Fundus photo. 2352 x 1568 pixels — 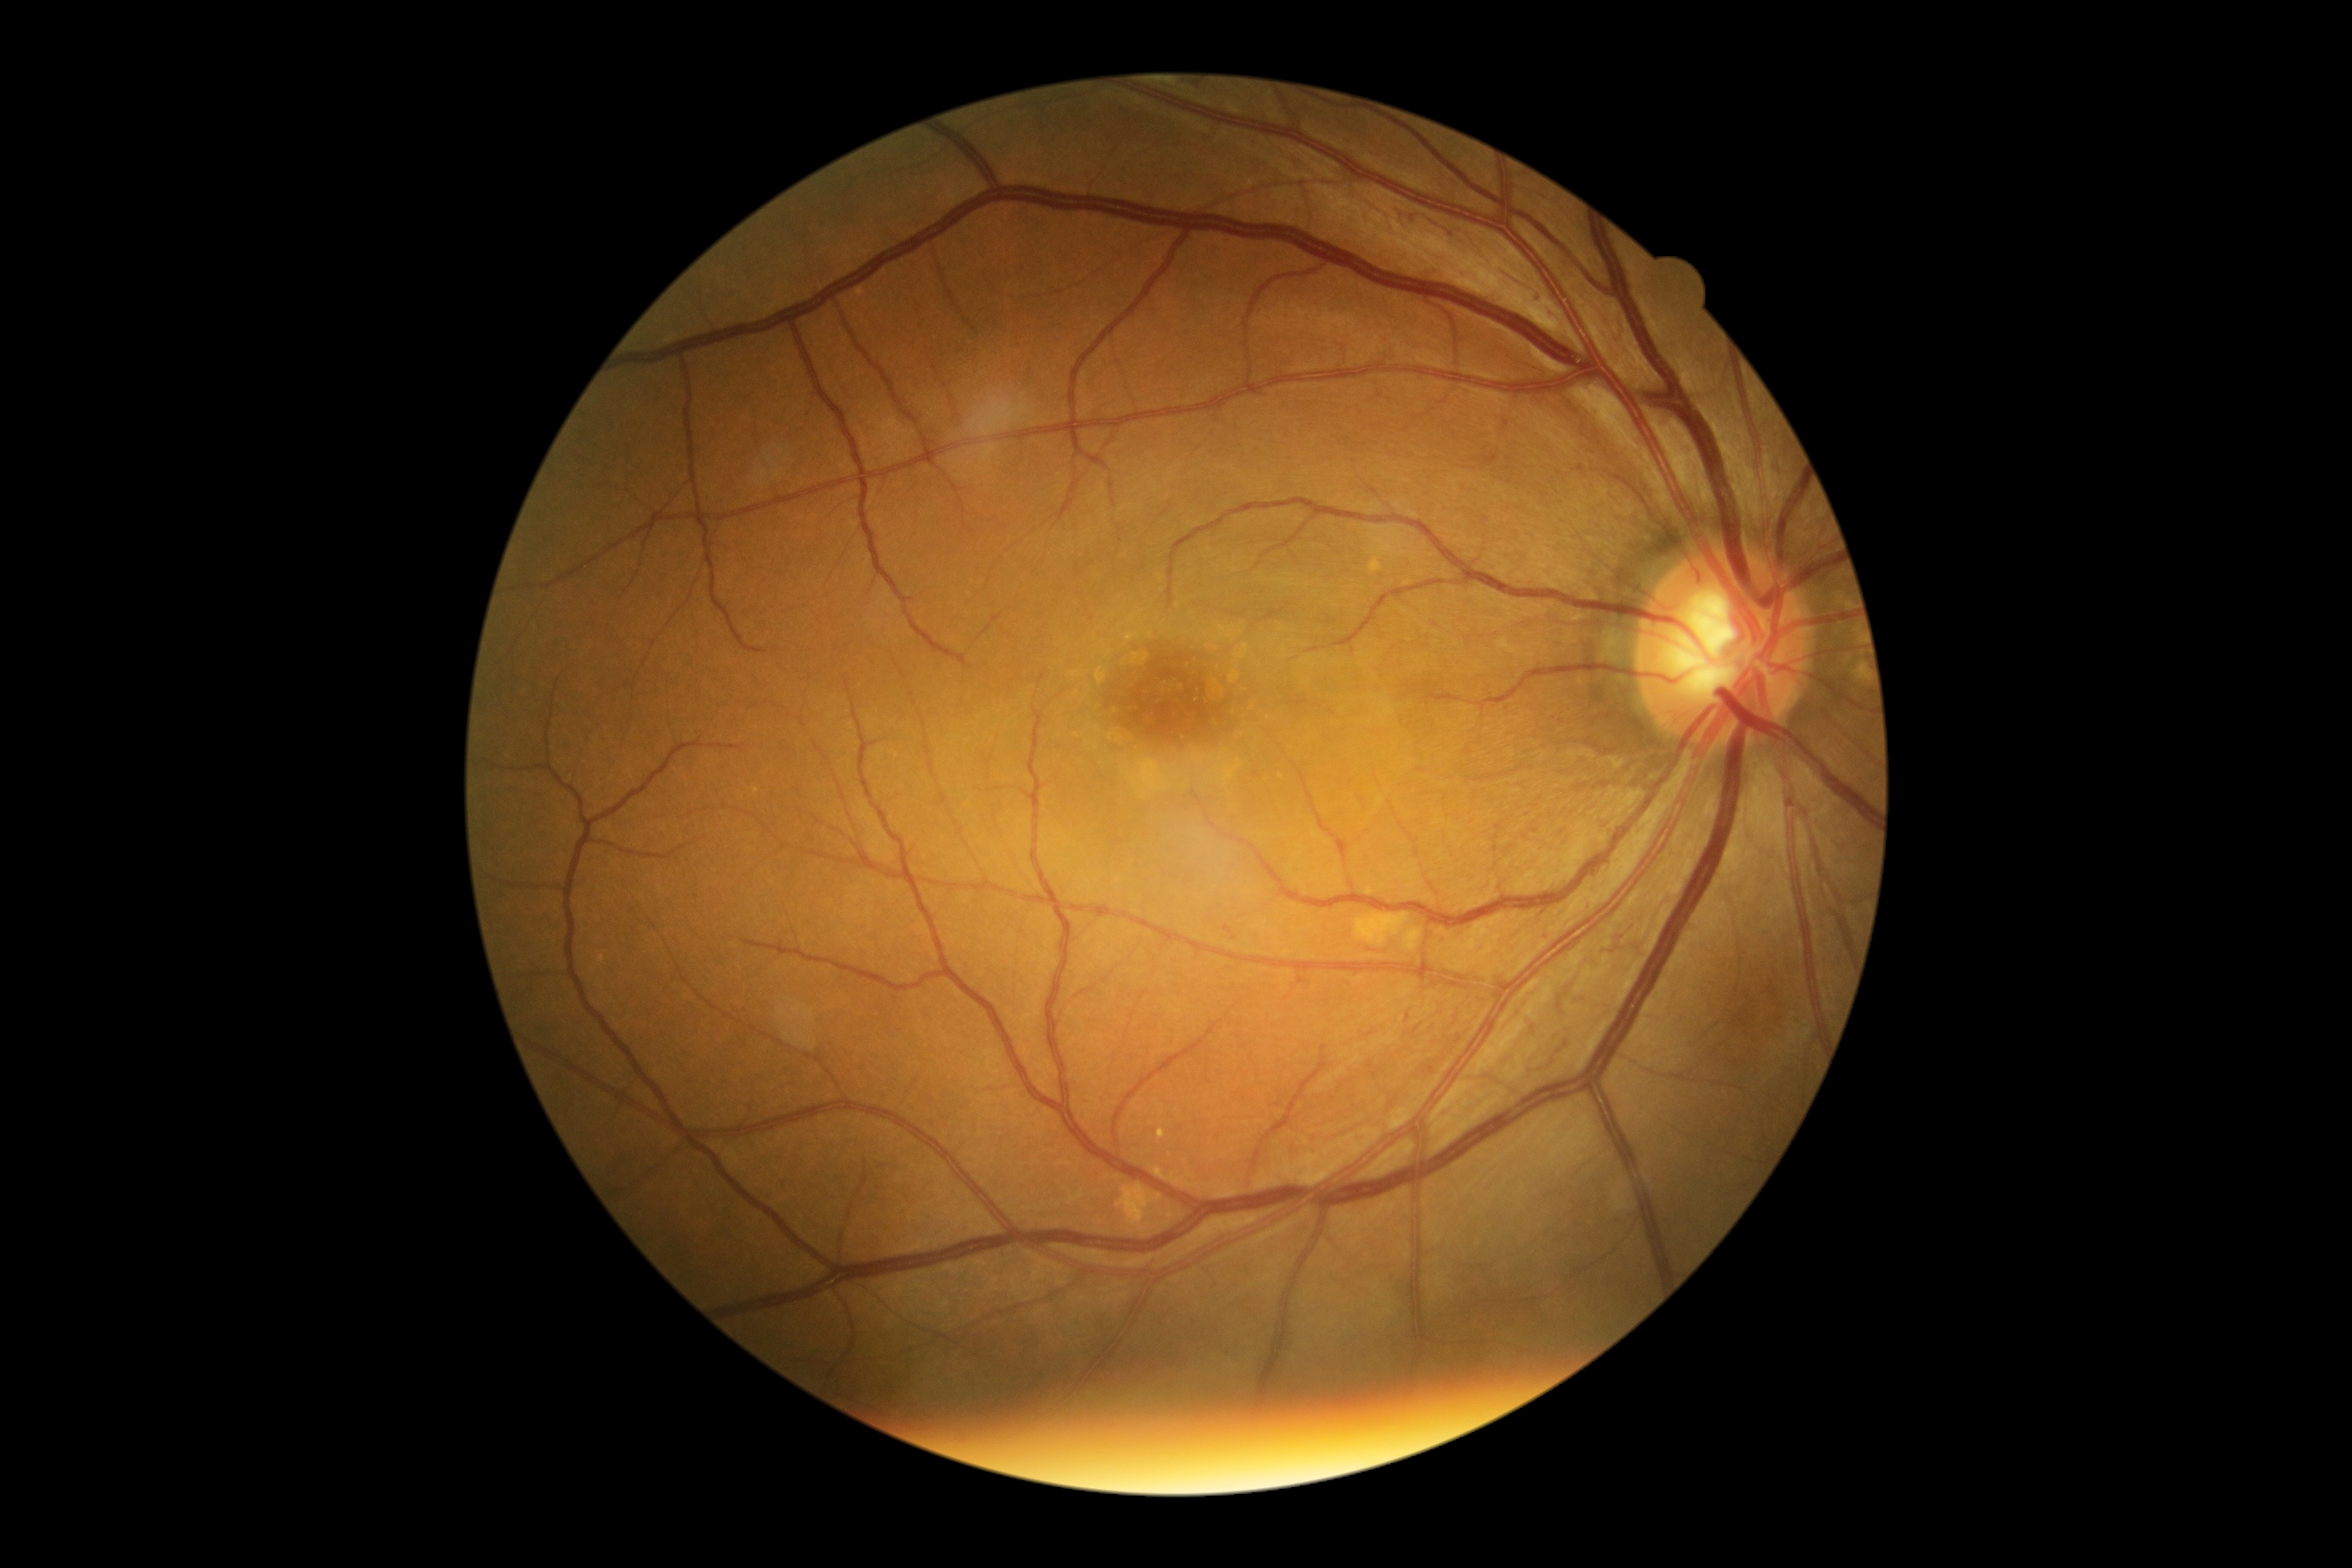

• retinopathy — 3 — more than 20 intraretinal hemorrhages in each of 4 quadrants, definite venous beading in 2 or more quadrants, or prominent intraretinal microvascular abnormalities in 1 or more quadrants, with no signs of proliferative retinopathy